Infant wide-field fundus photograph: 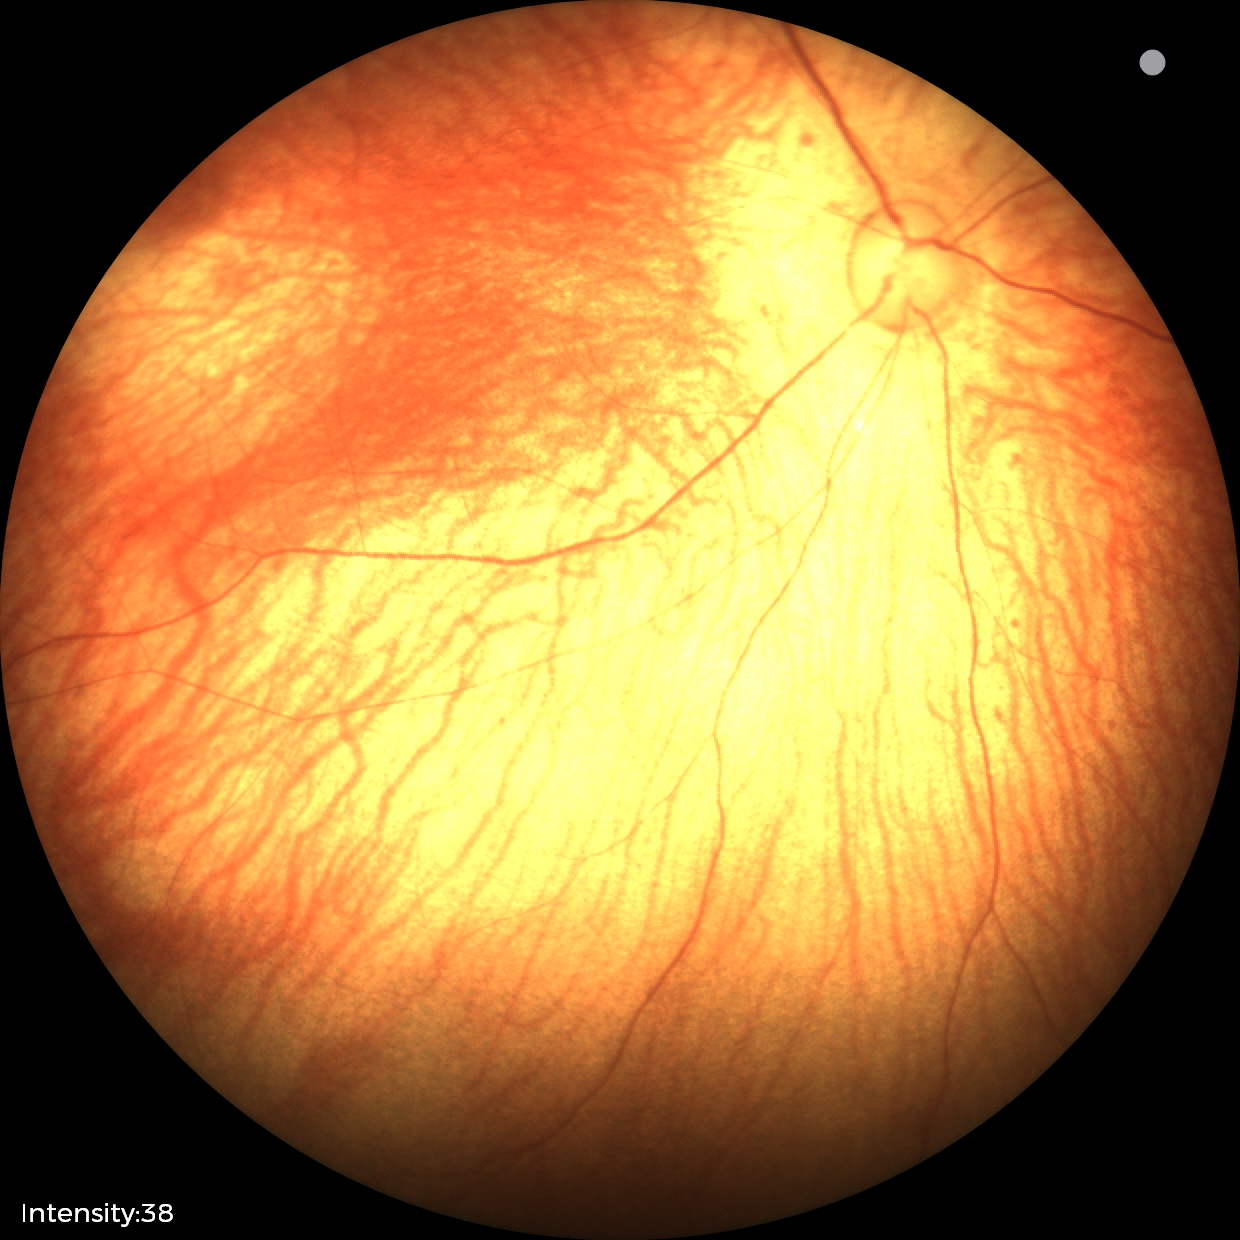
Screening examination with no abnormal retinal findings.